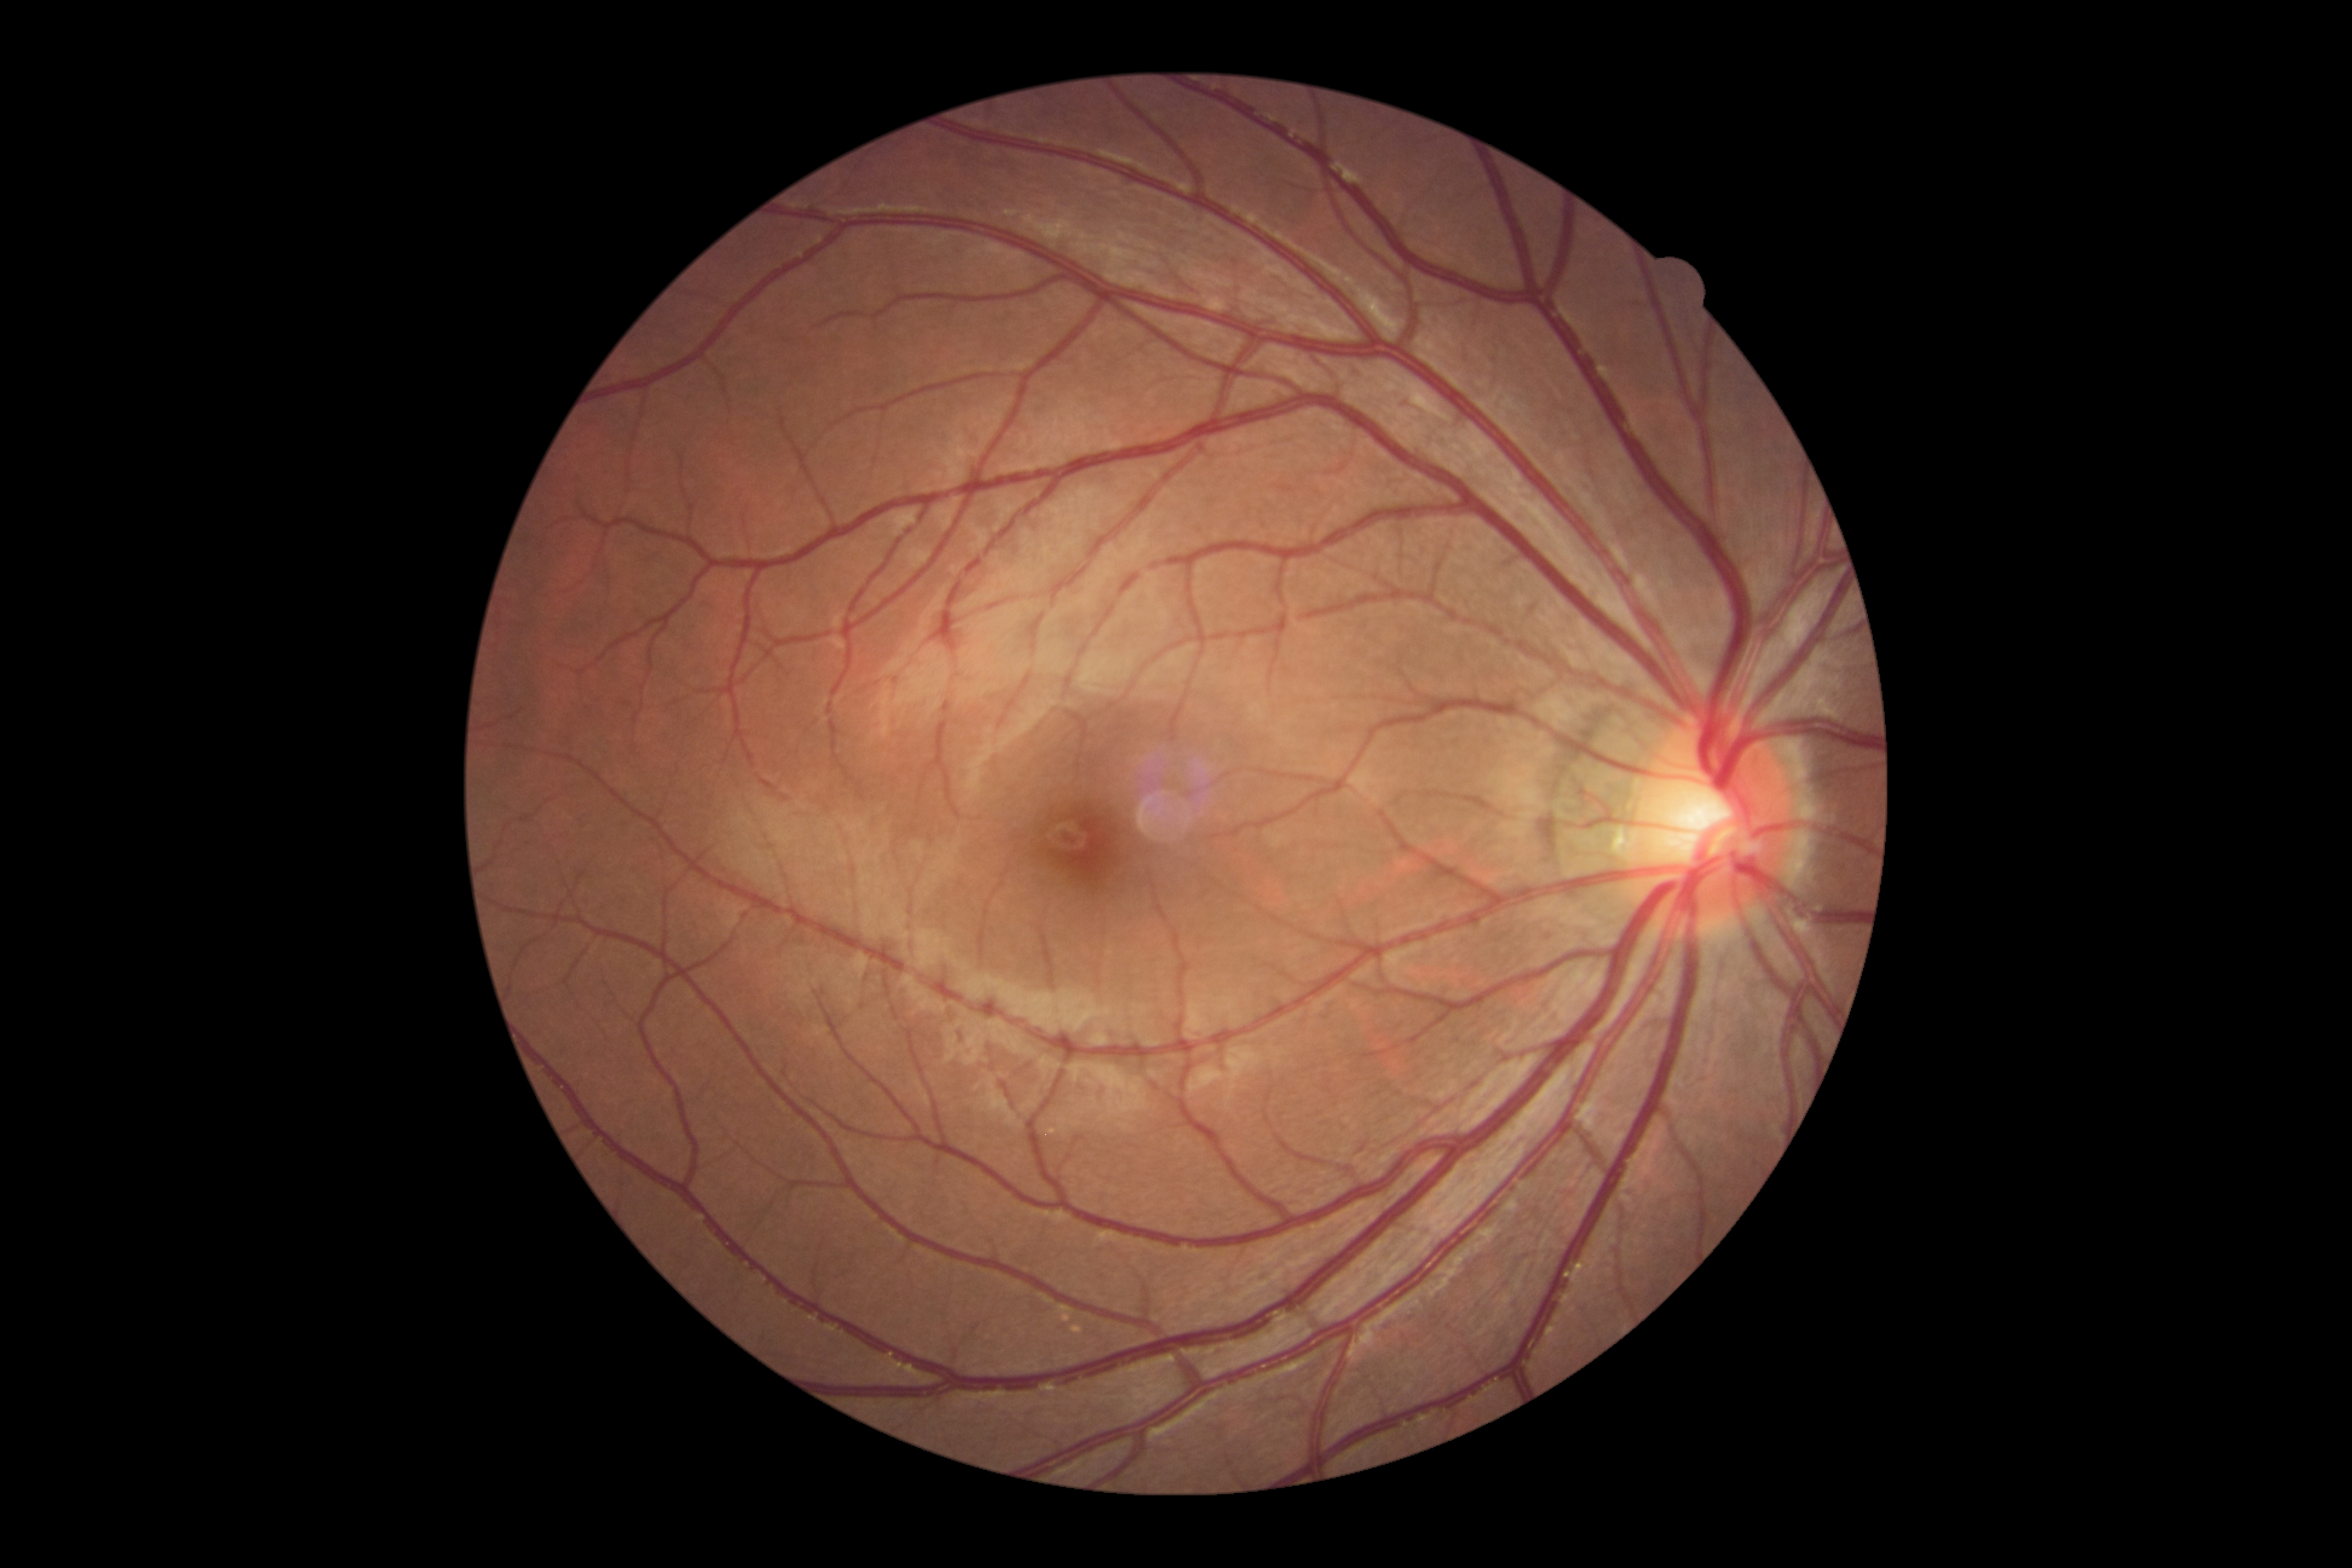
diabetic retinopathy (DR) = 0/4